Infant wide-field retinal image.
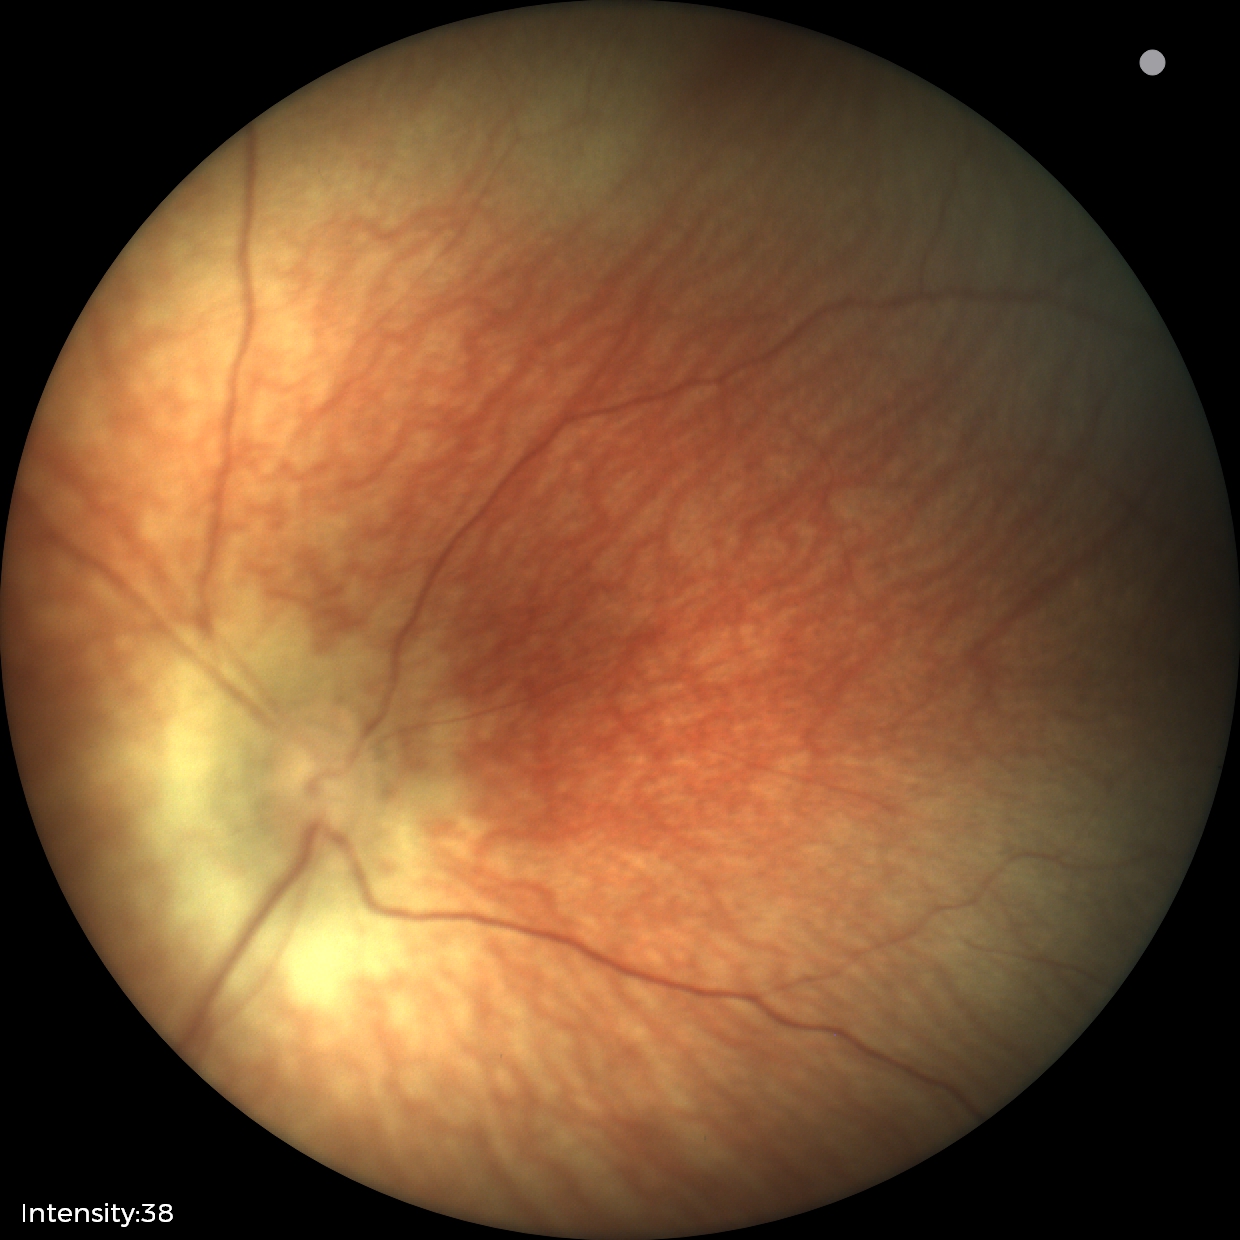
Q: What is the diagnosis from this examination?
A: normal retinal appearance